640x480. Wide-field contact fundus photograph of an infant
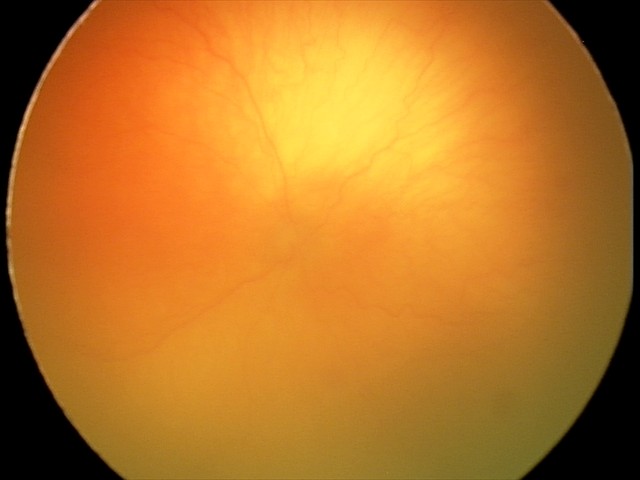 Series diagnosed as aggressive retinopathy of prematurity.